Fundus photo: 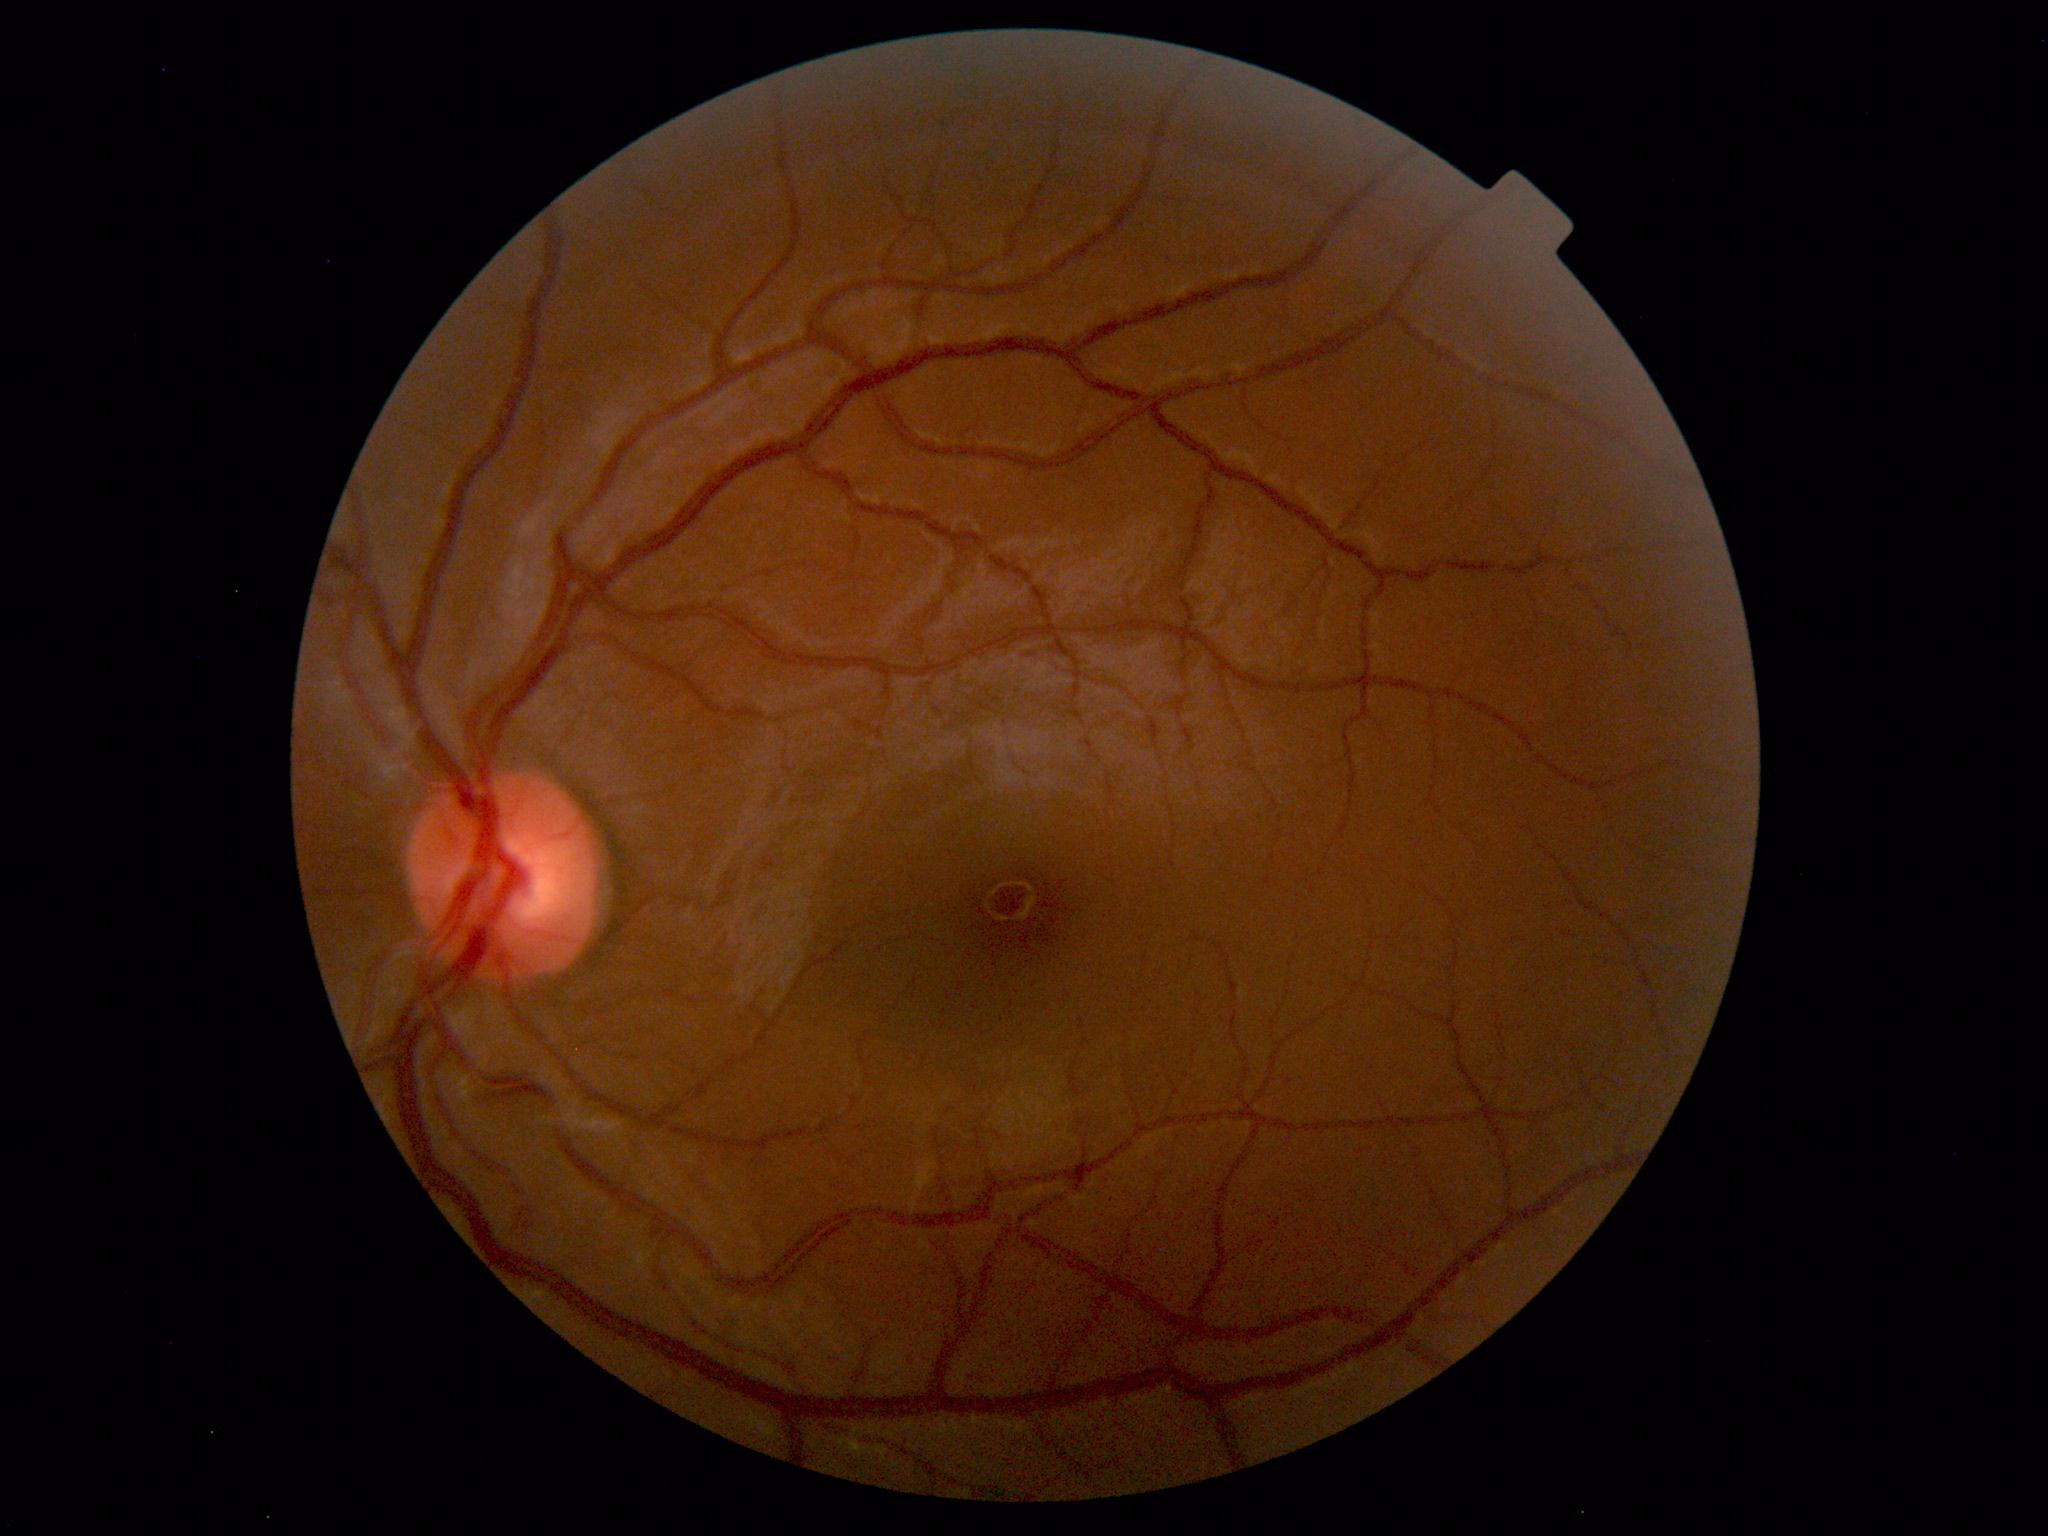

Within normal limits. No abnormalities identified.